Fundus photo: 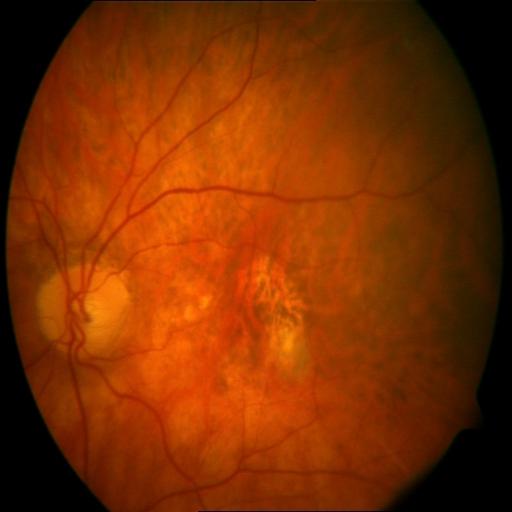 Impression: myopia, hemorrhagic retinopathy, tessellation.